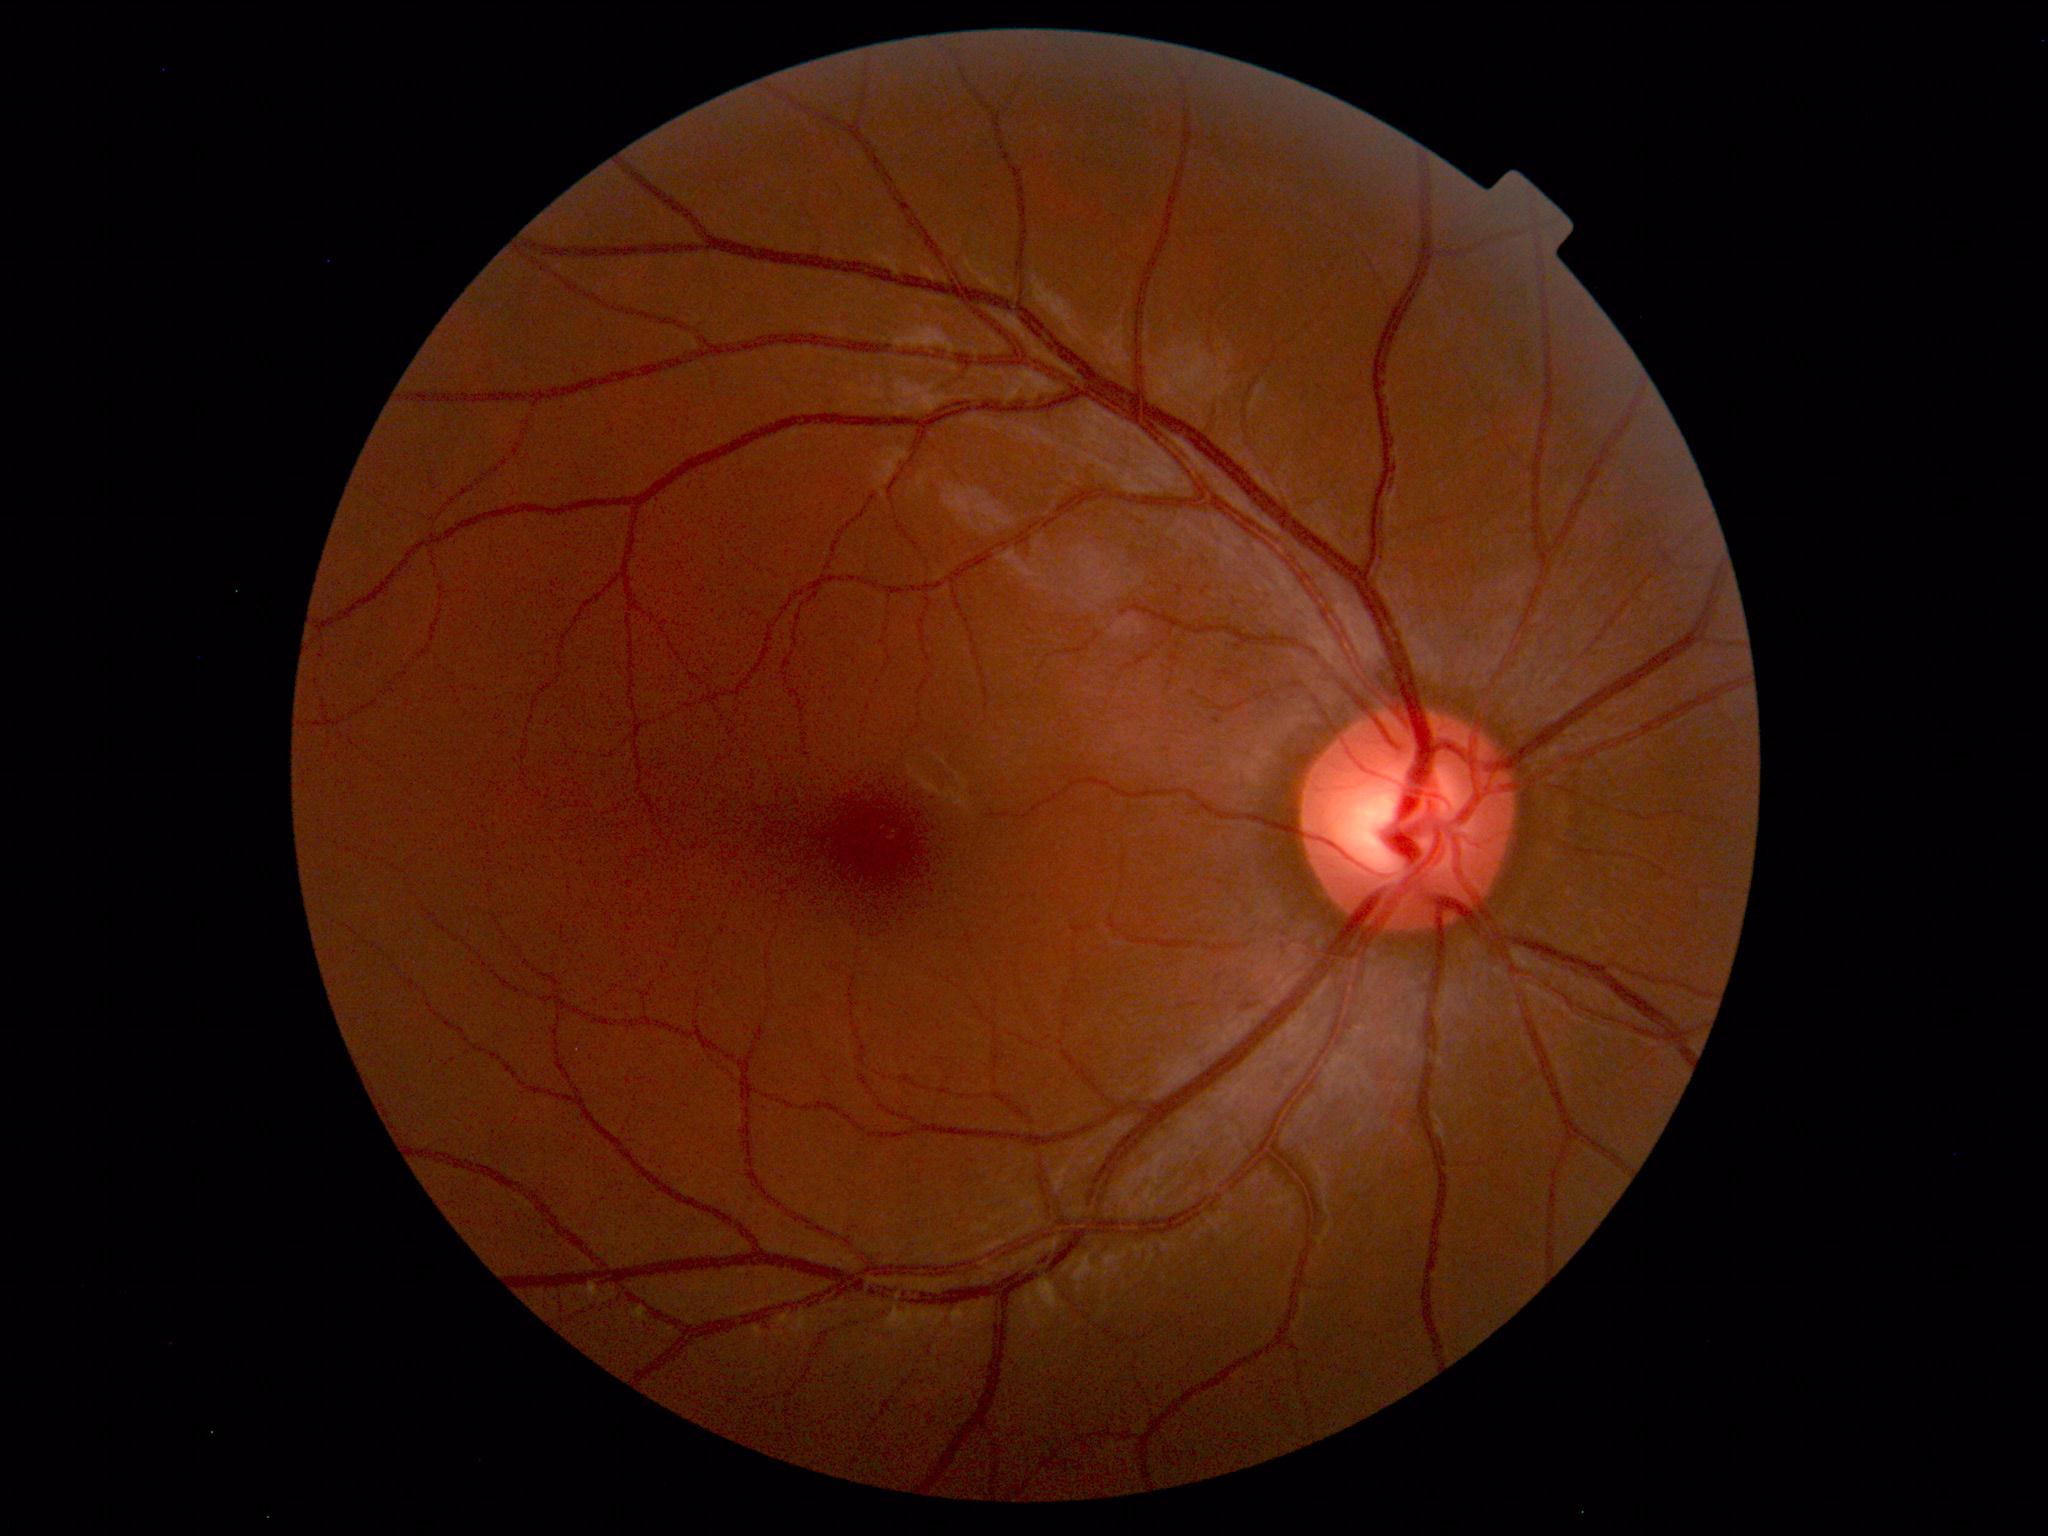 Normal fundus. No pathology identified.